45° field of view — 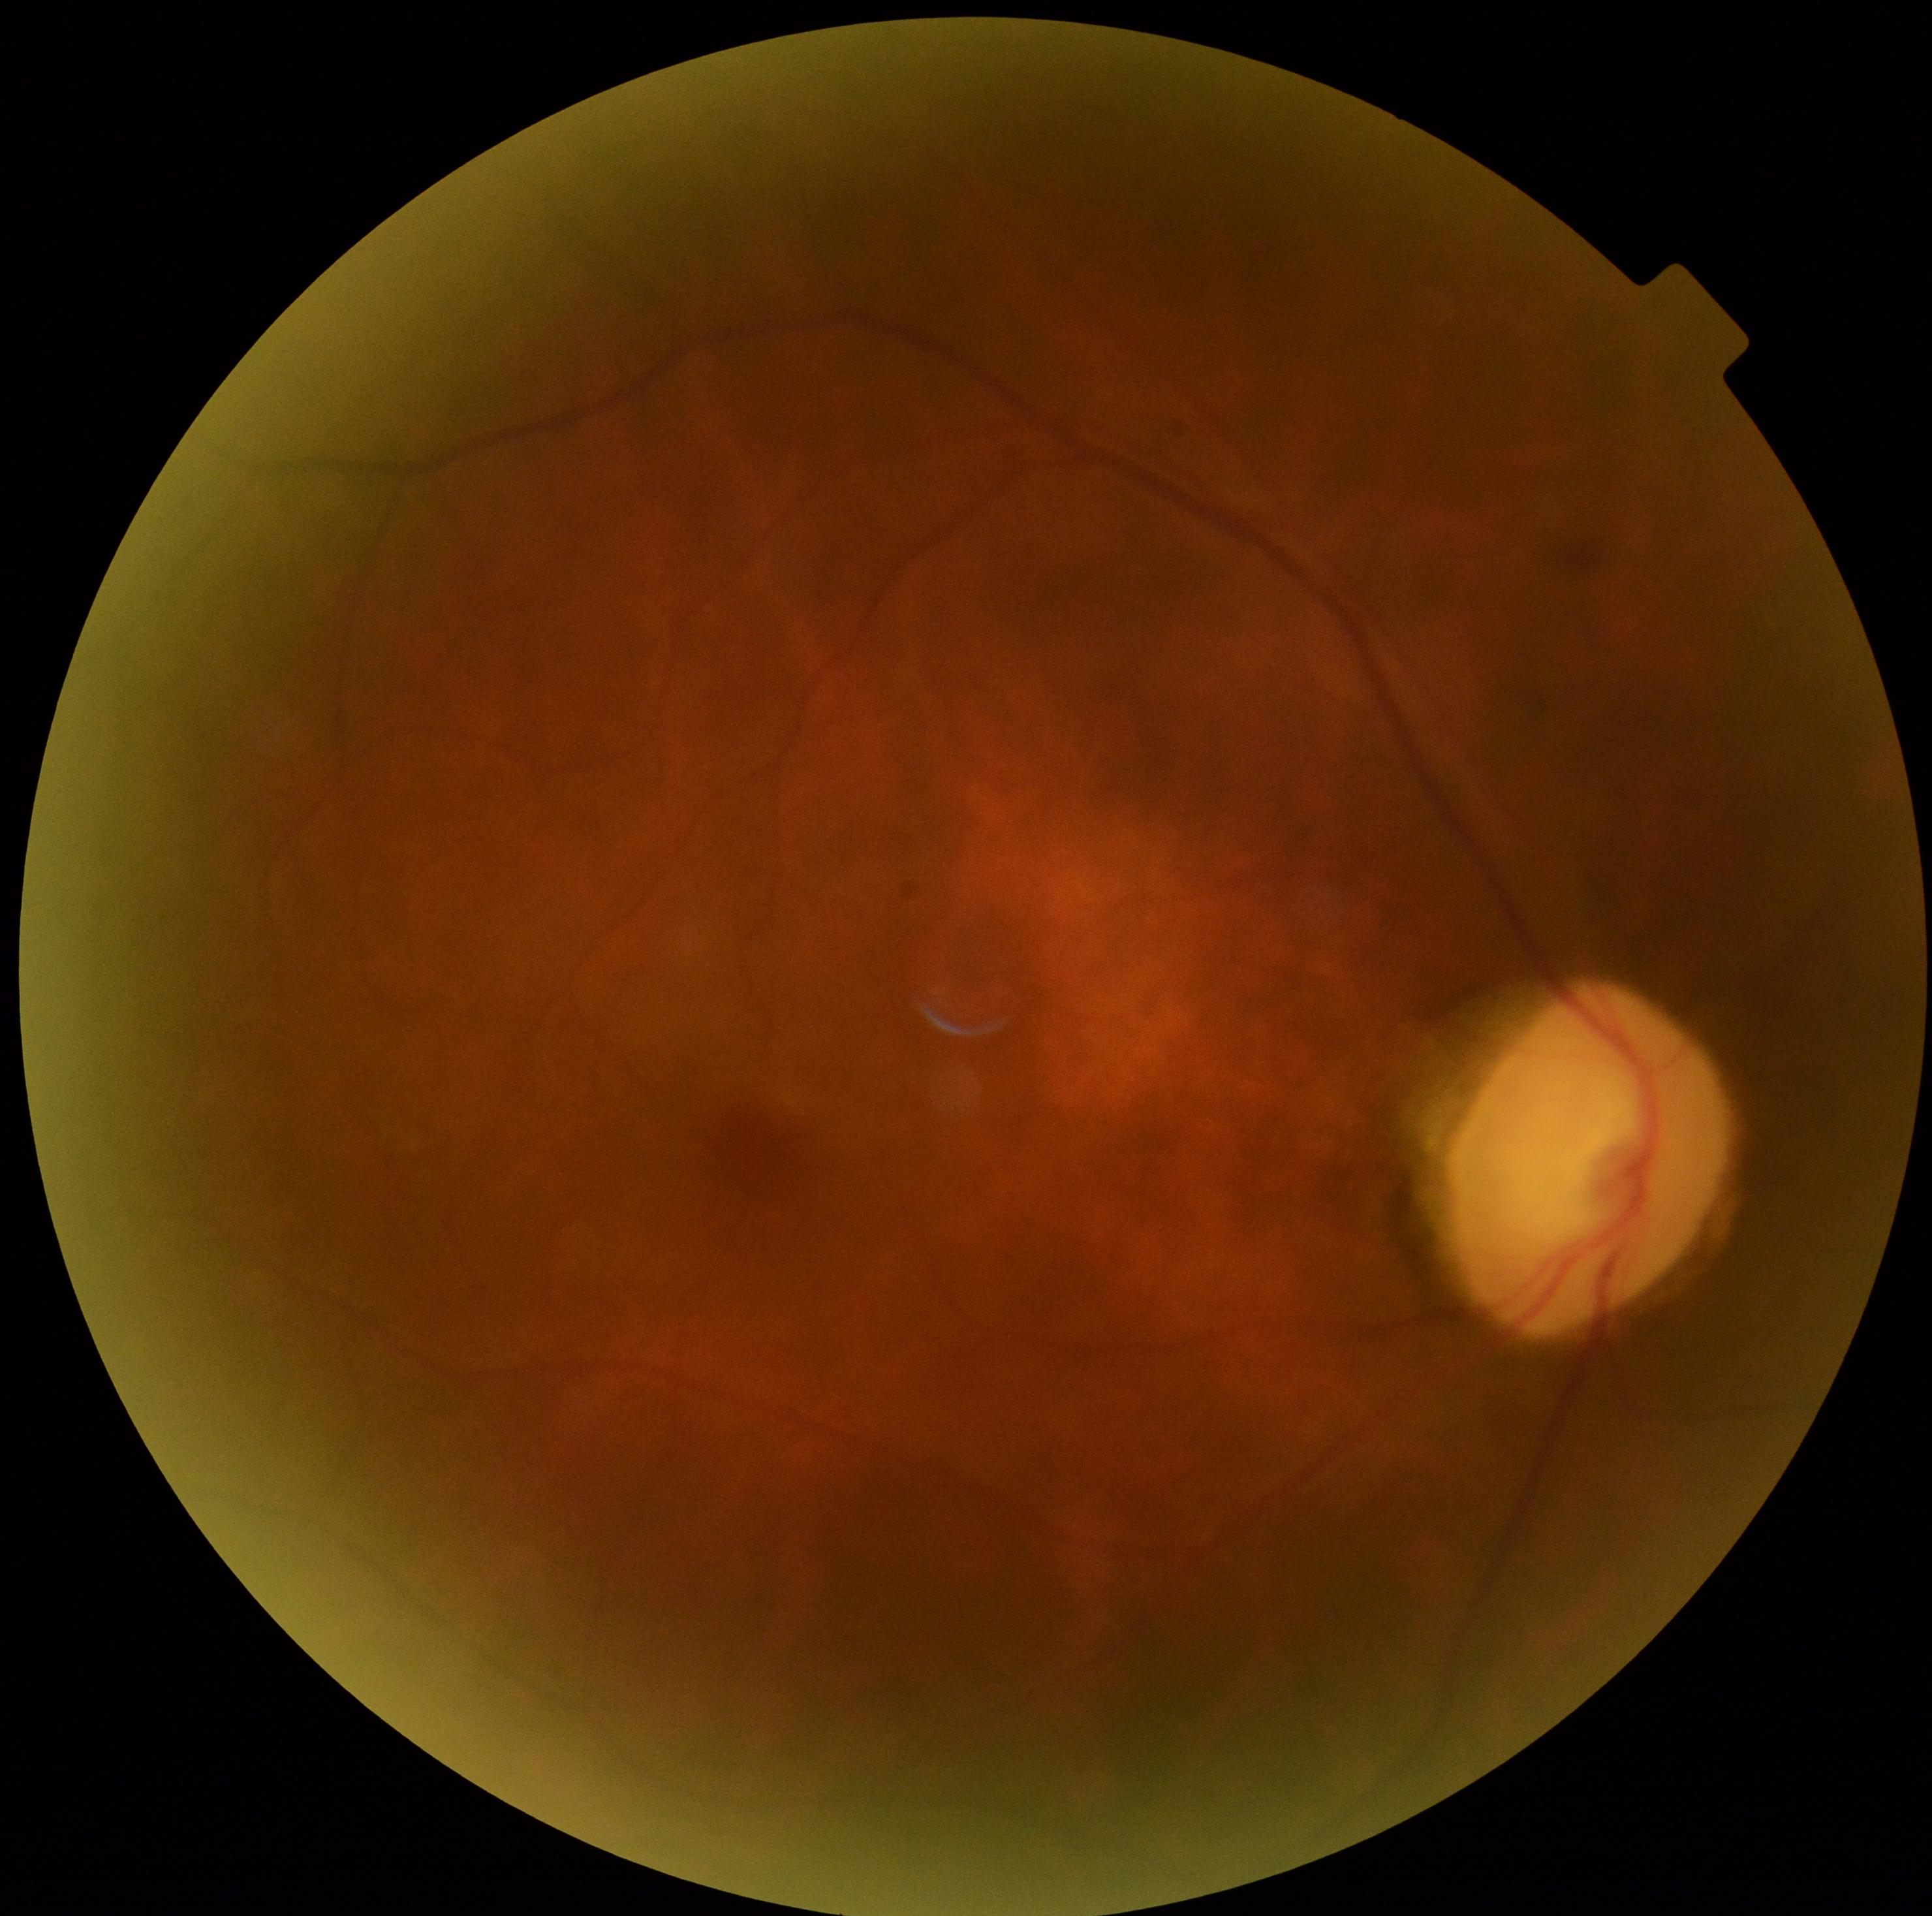

DR stage: grade 0 (no apparent retinopathy).